2352 by 1568 pixels
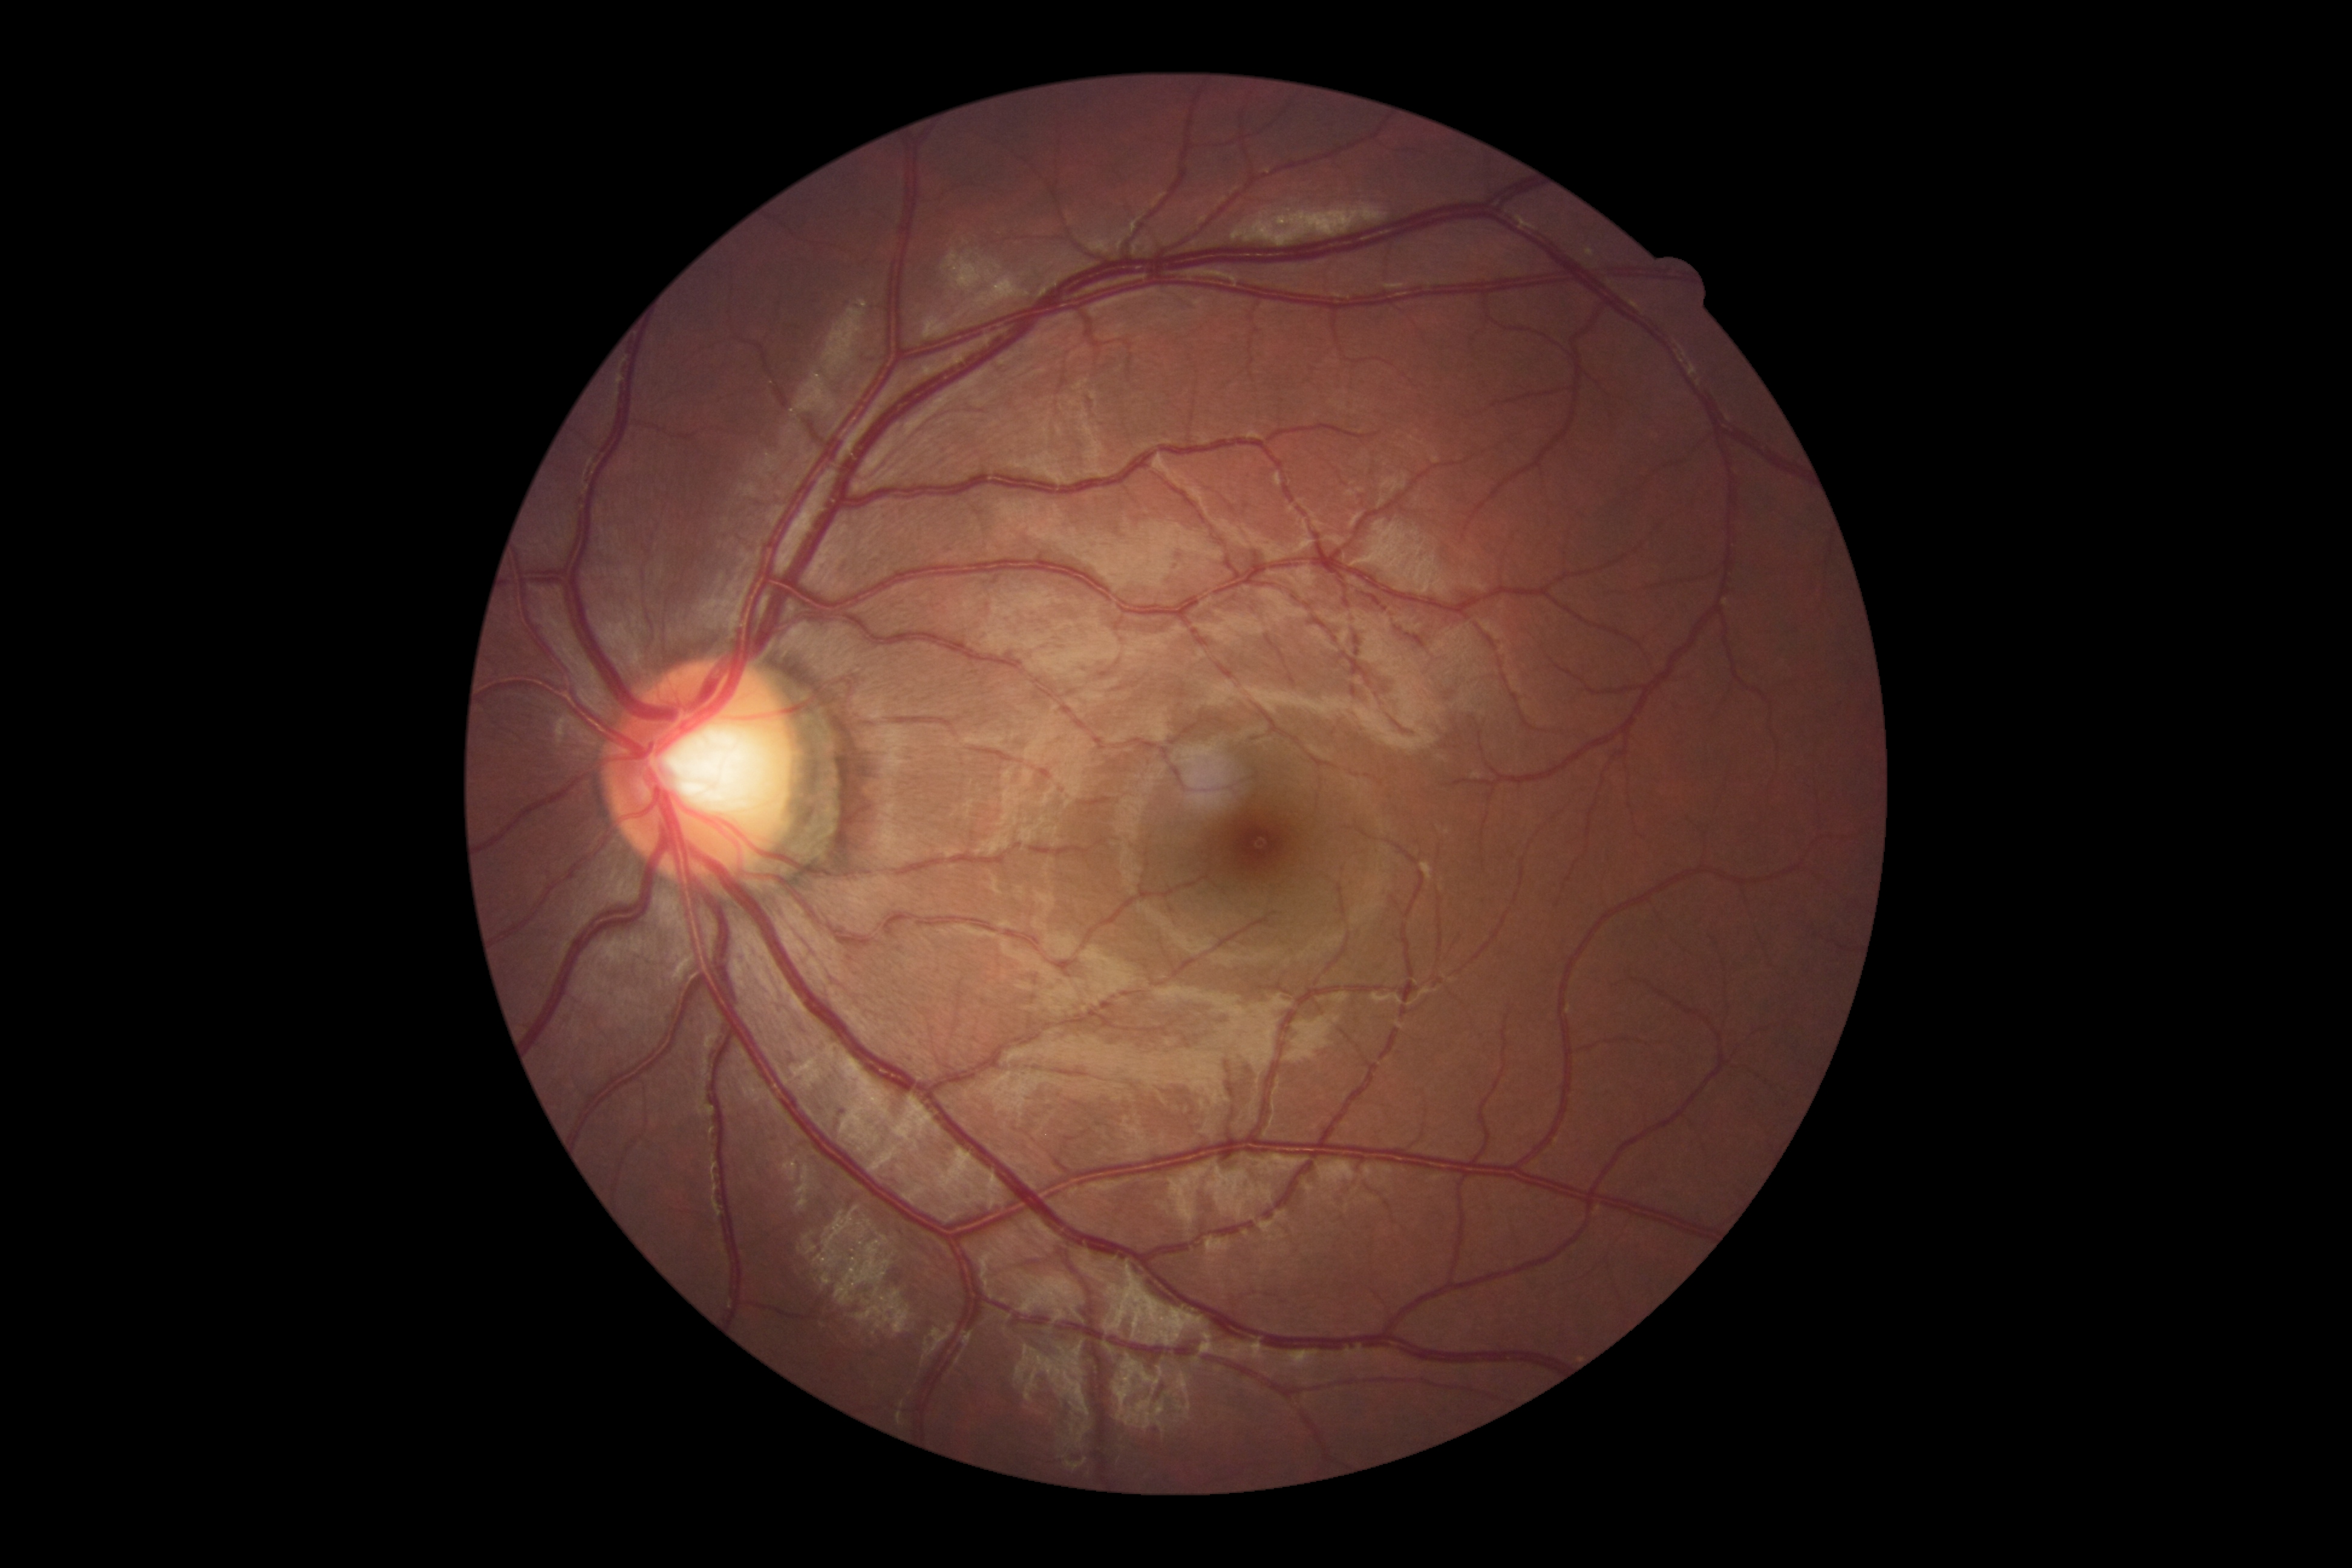

DR = grade 0.